Color fundus photograph, 45-degree field of view
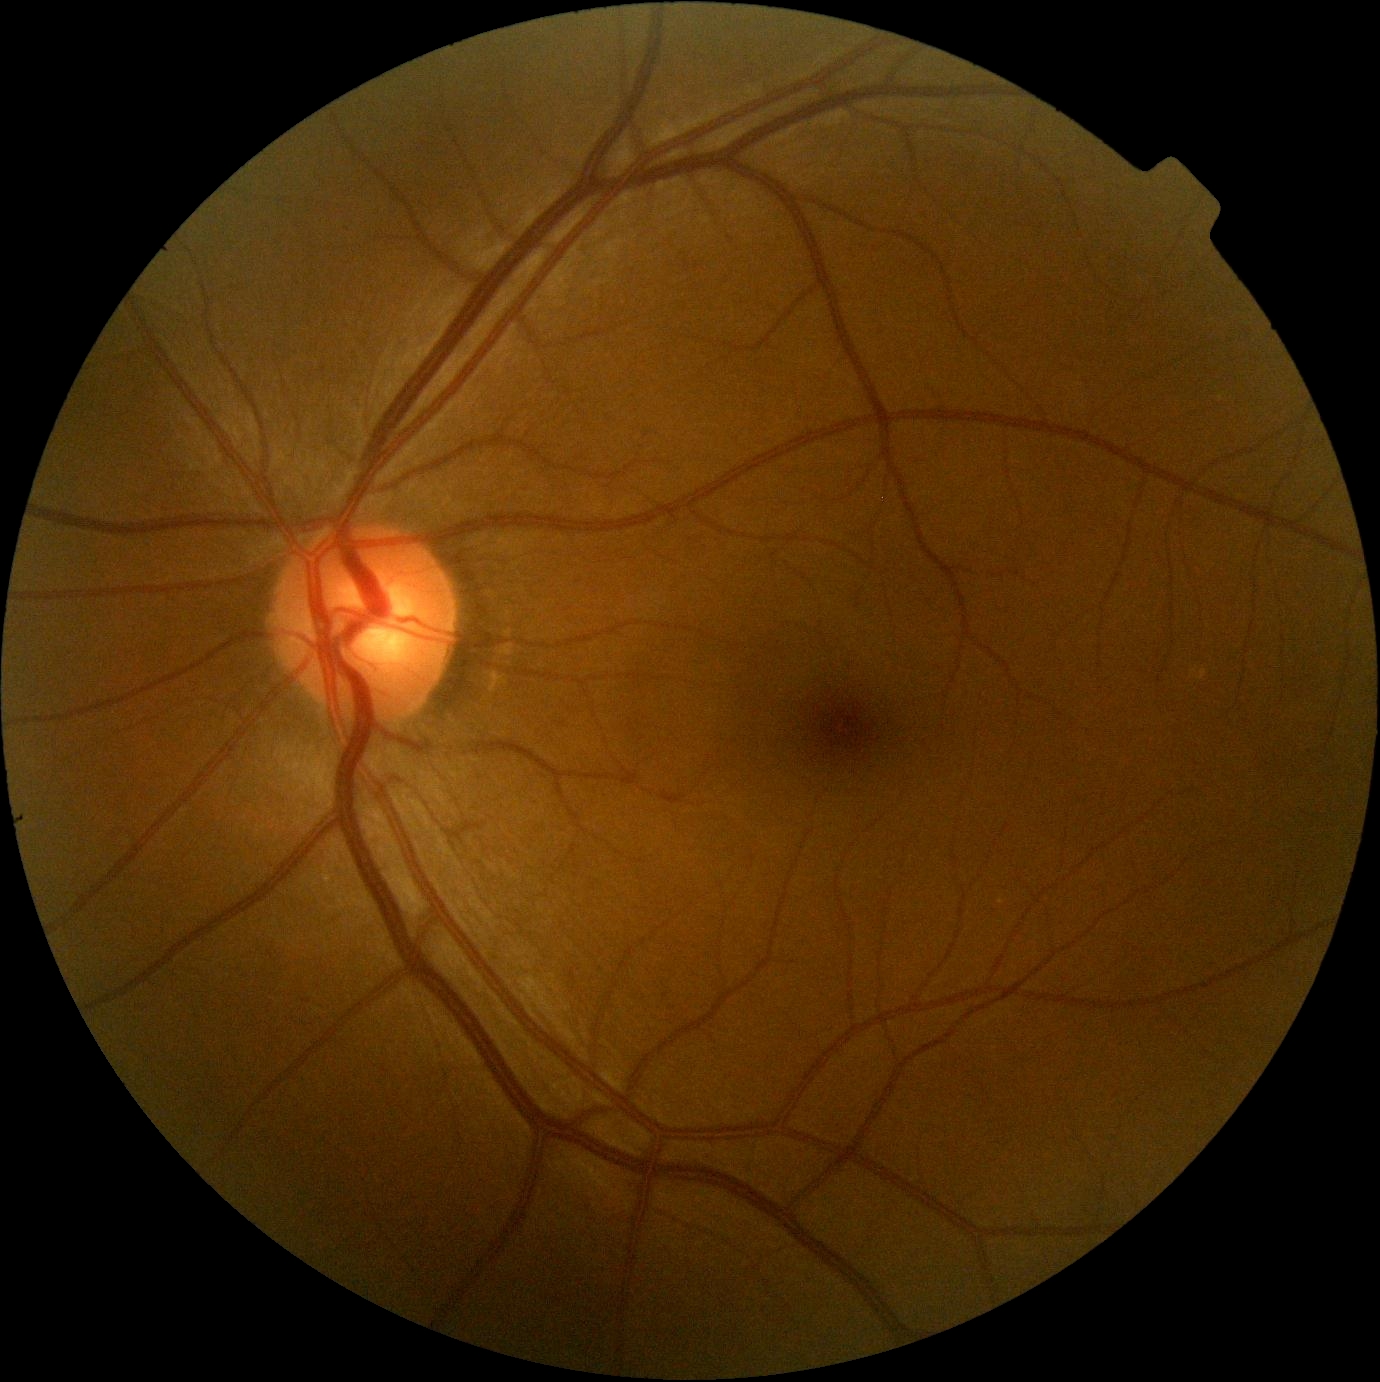

DR impression: no DR findings | DR grade: 0.